1932x1932, 45° FOV
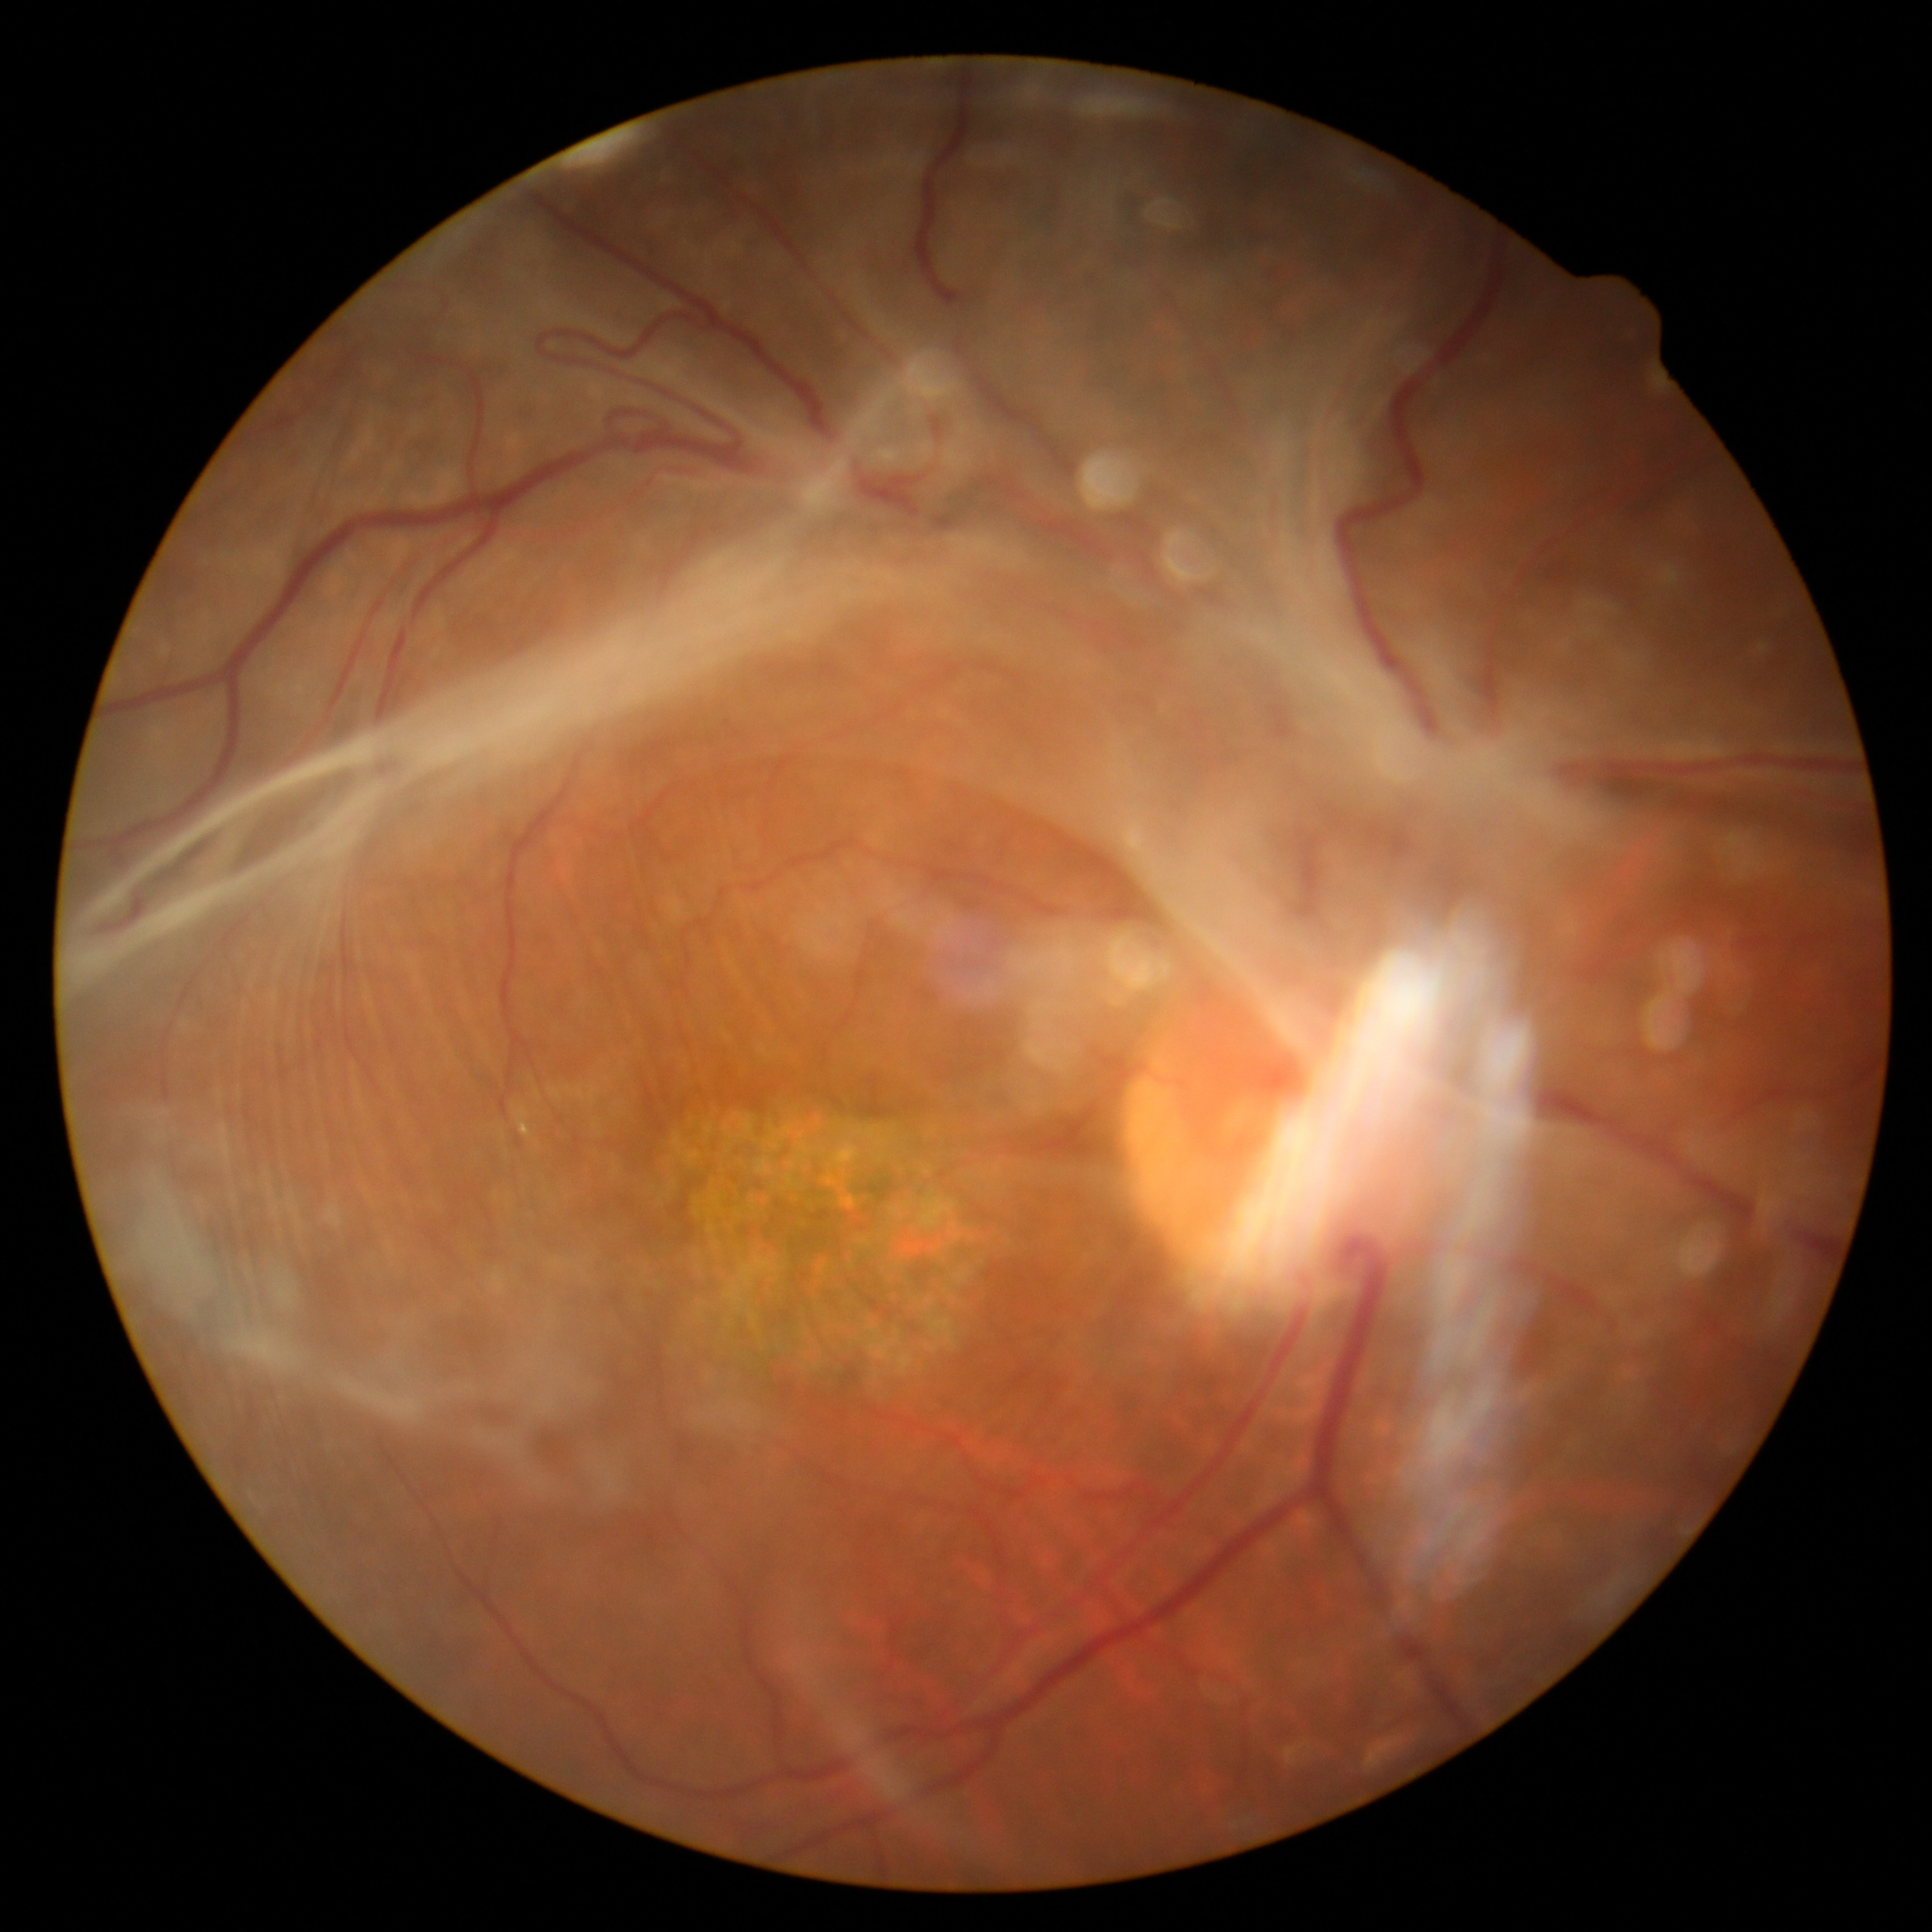
DR: grade 4 (PDR).